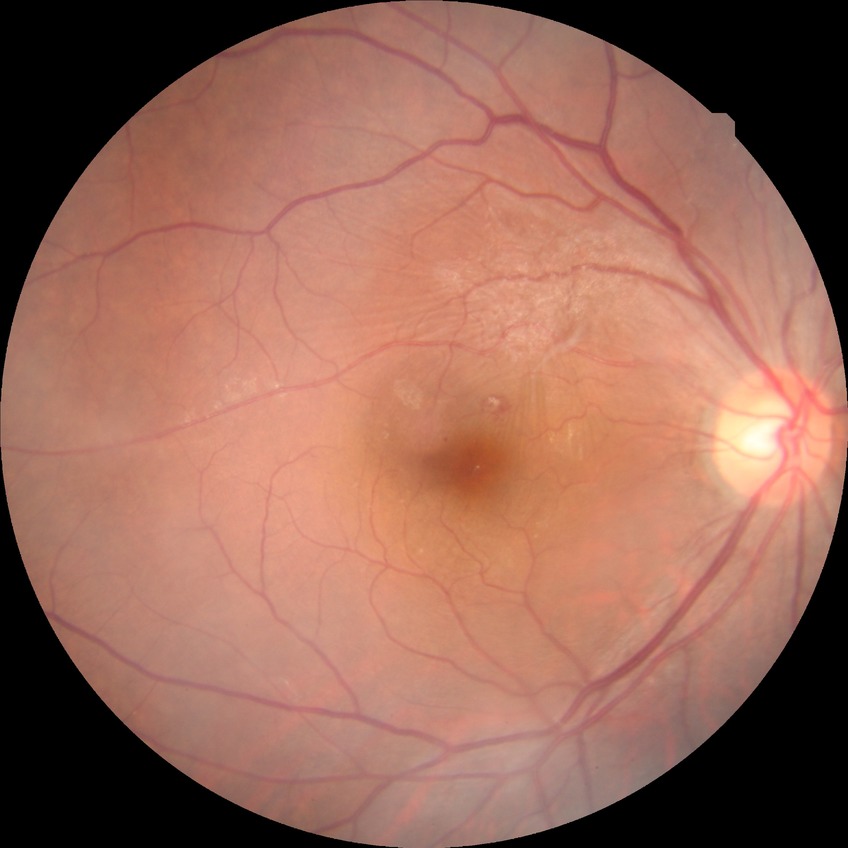

Diabetic retinopathy (DR): simple diabetic retinopathy (SDR).